Color fundus photograph. 45-degree field of view: 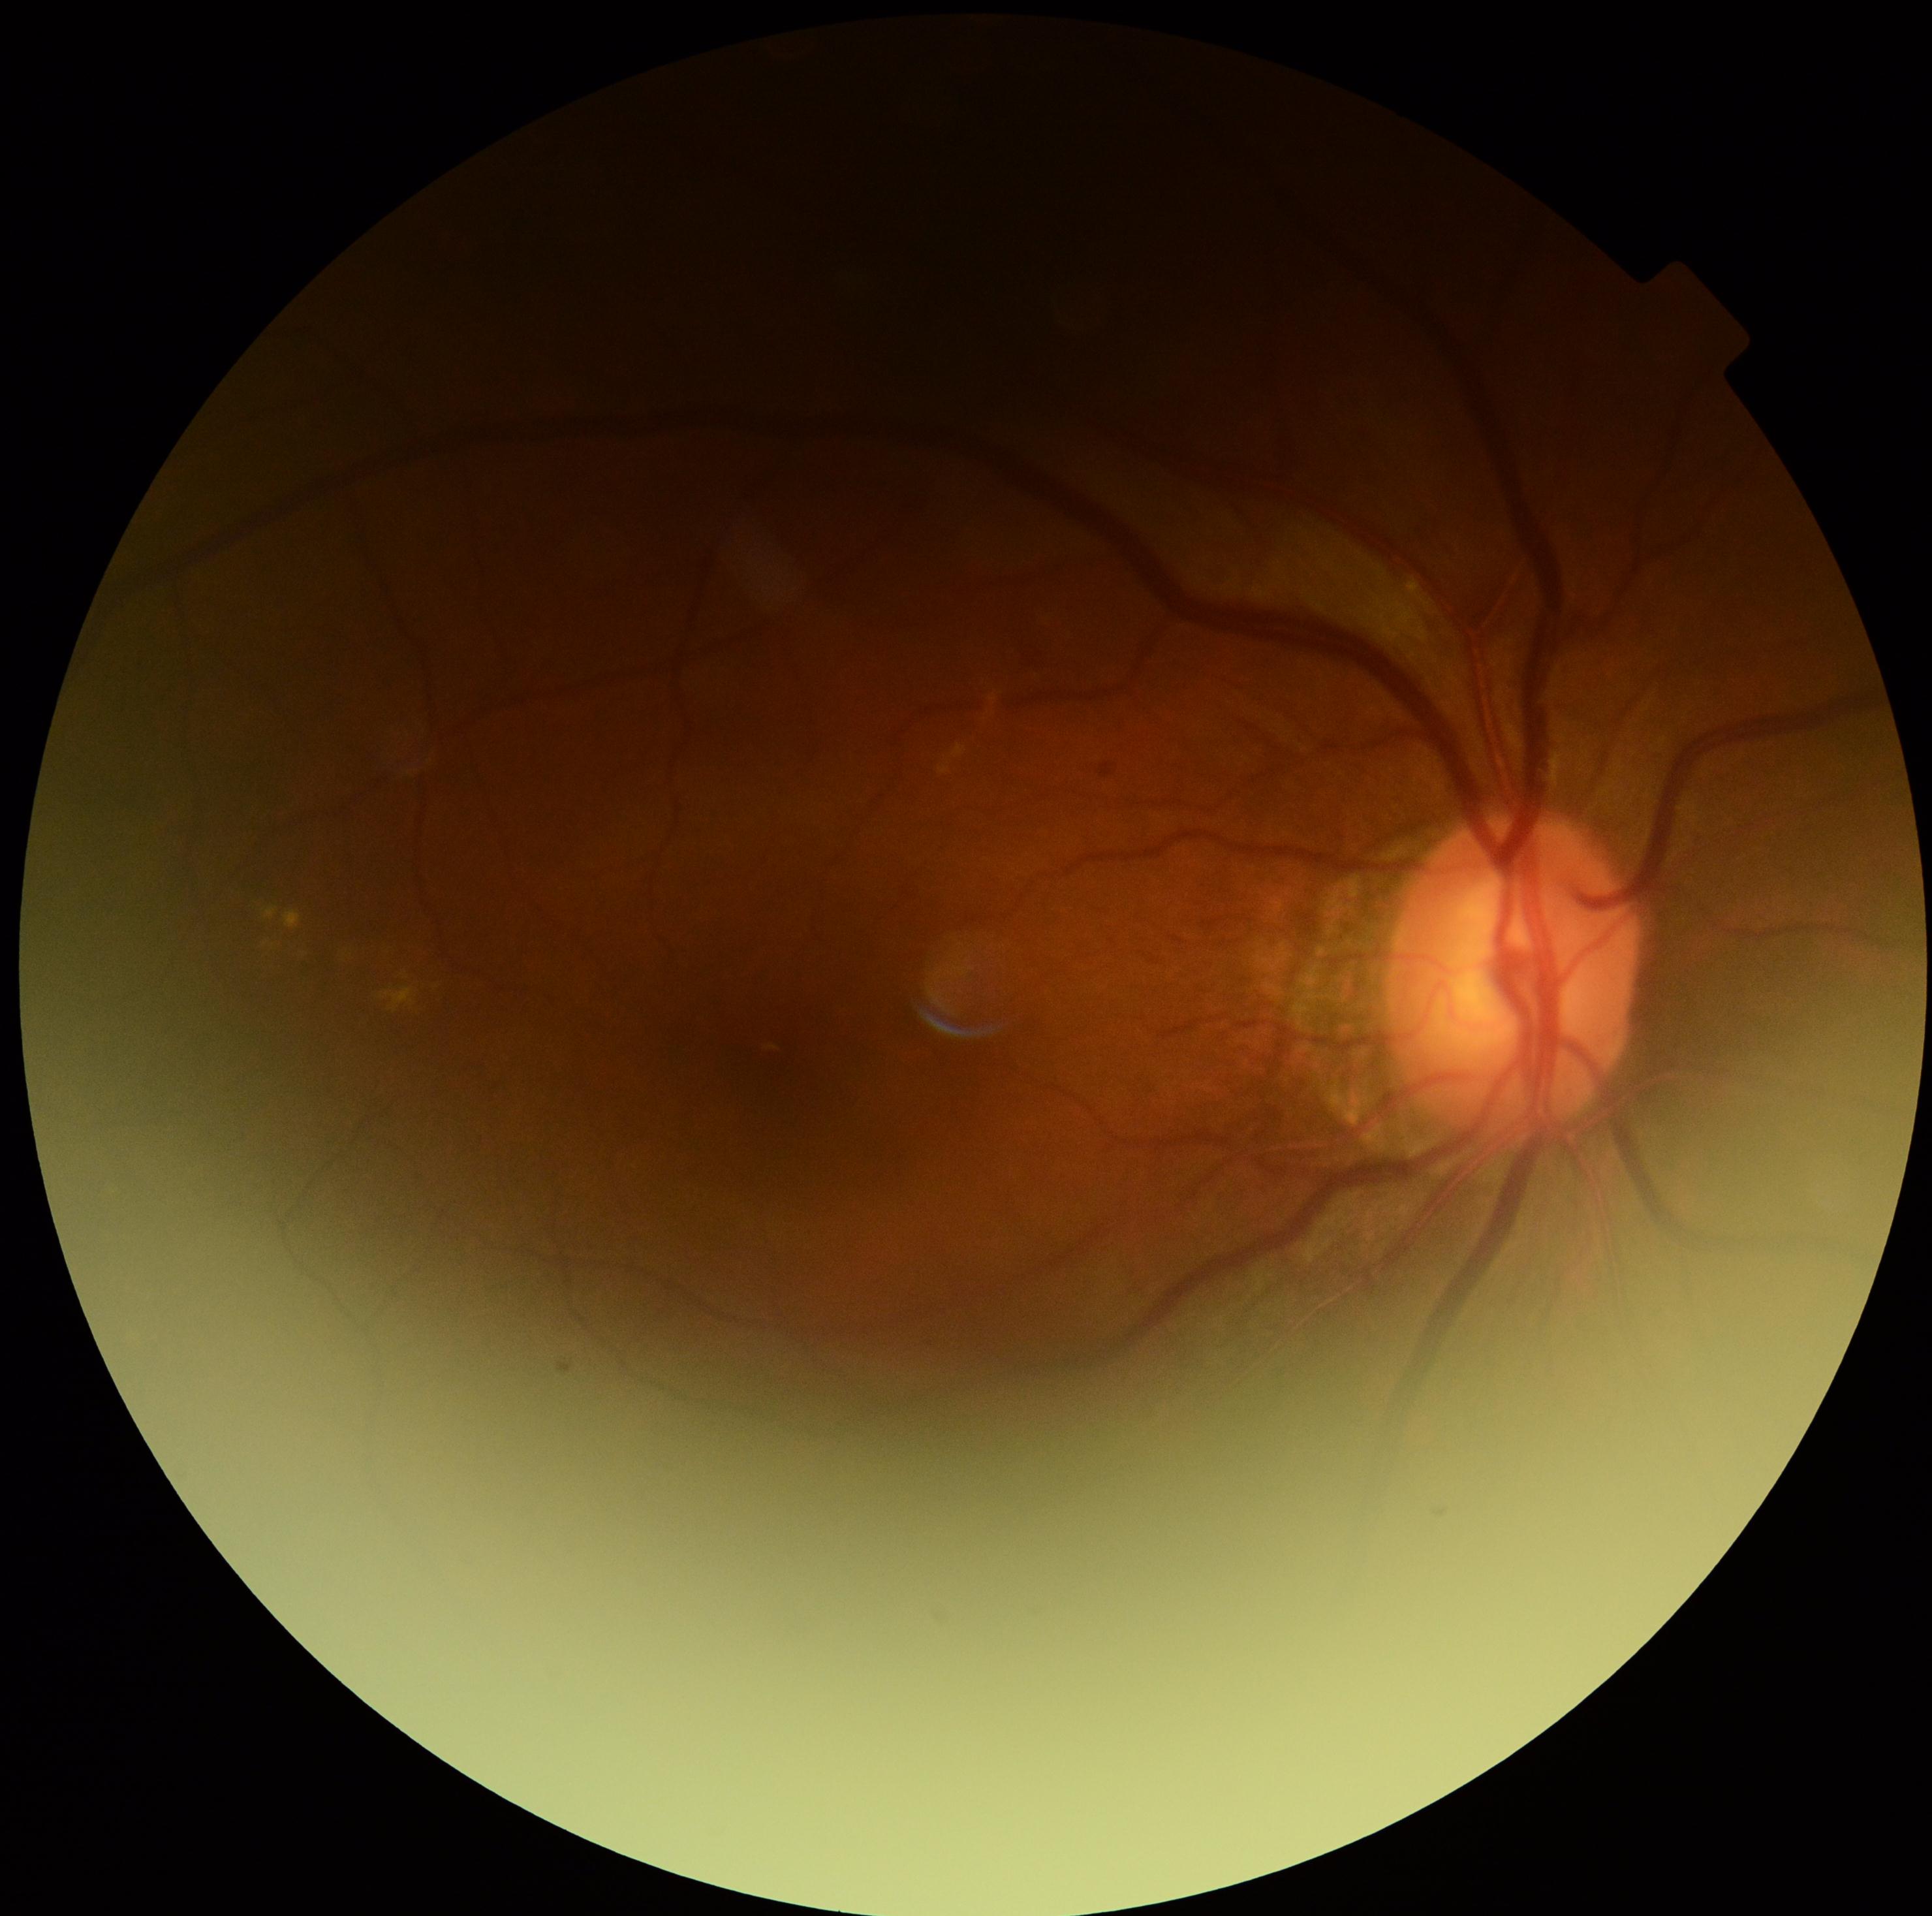 Disease class: non-proliferative diabetic retinopathy. Retinopathy is moderate NPDR (grade 2).